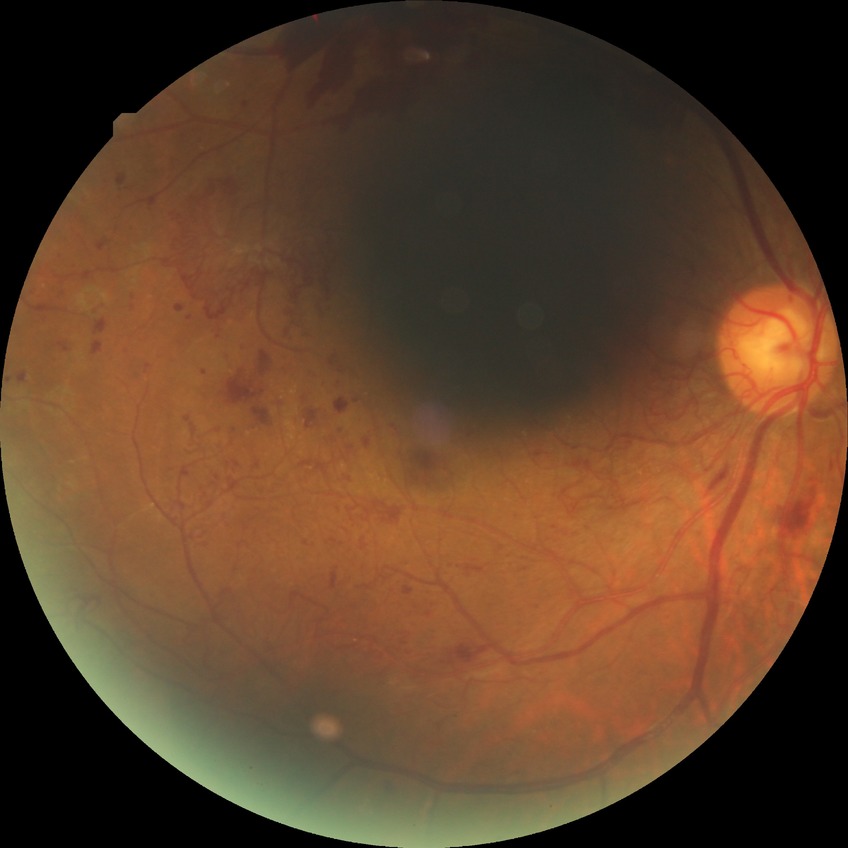 {"davis_grade": "proliferative diabetic retinopathy"}